Camera: NIDEK AFC-230; 848 by 848 pixels; posterior pole color fundus photograph — 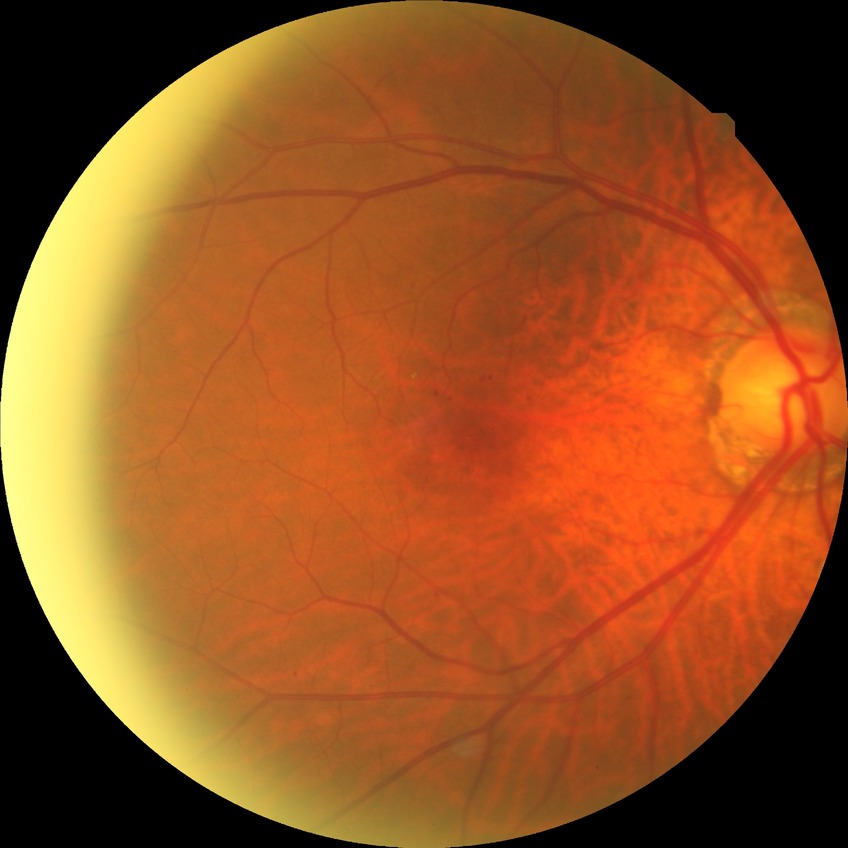
  davis_grade: simple diabetic retinopathy (SDR)